Nonmydriatic fundus photograph; retinal fundus photograph; 848 by 848 pixels; FOV: 45 degrees; NIDEK AFC-230.
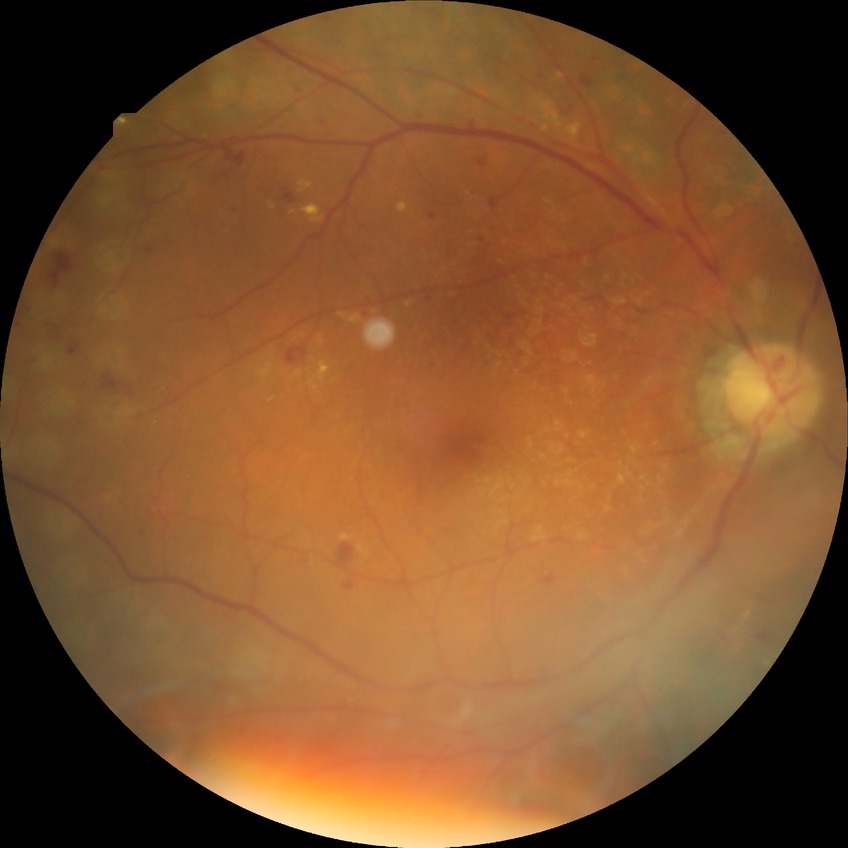

Diabetic retinopathy (DR): proliferative diabetic retinopathy (PDR).